Fundus photo.
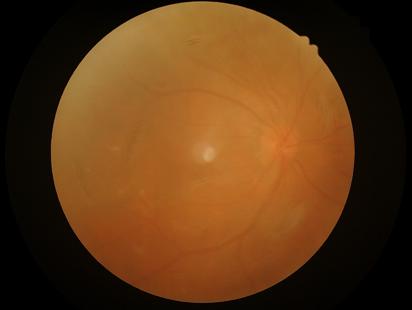 Quality grading: contrast: reduced | focus: reduced | overall: low | illumination/color: good.